Diabetic retinopathy graded by the modified Davis classification:
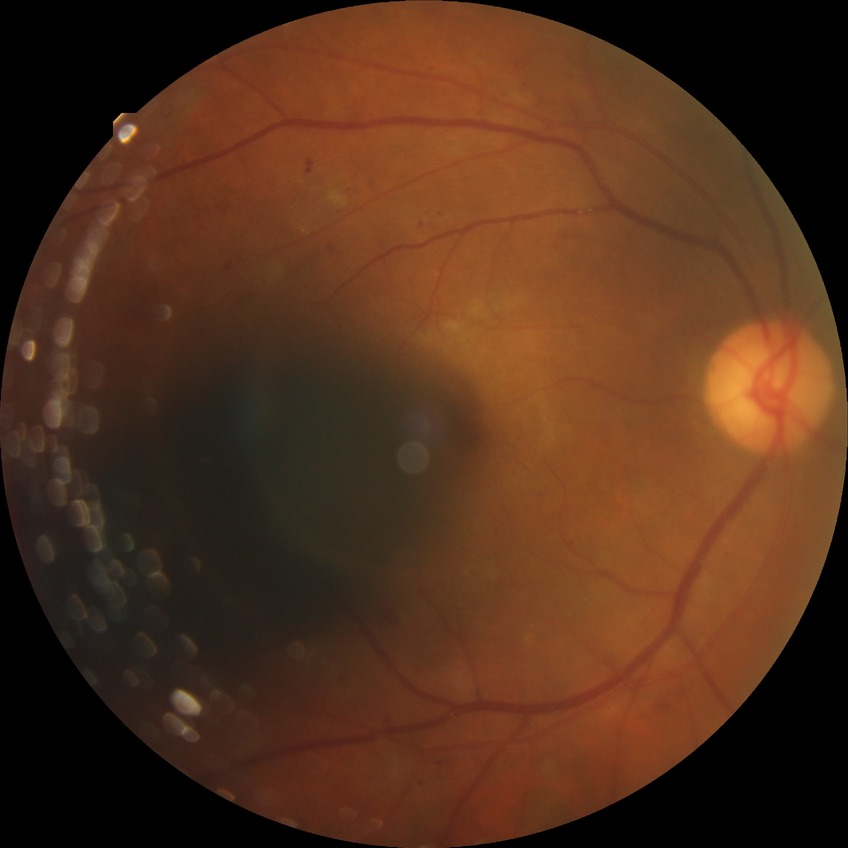 DR: PPDR.